45-degree field of view, CFP — 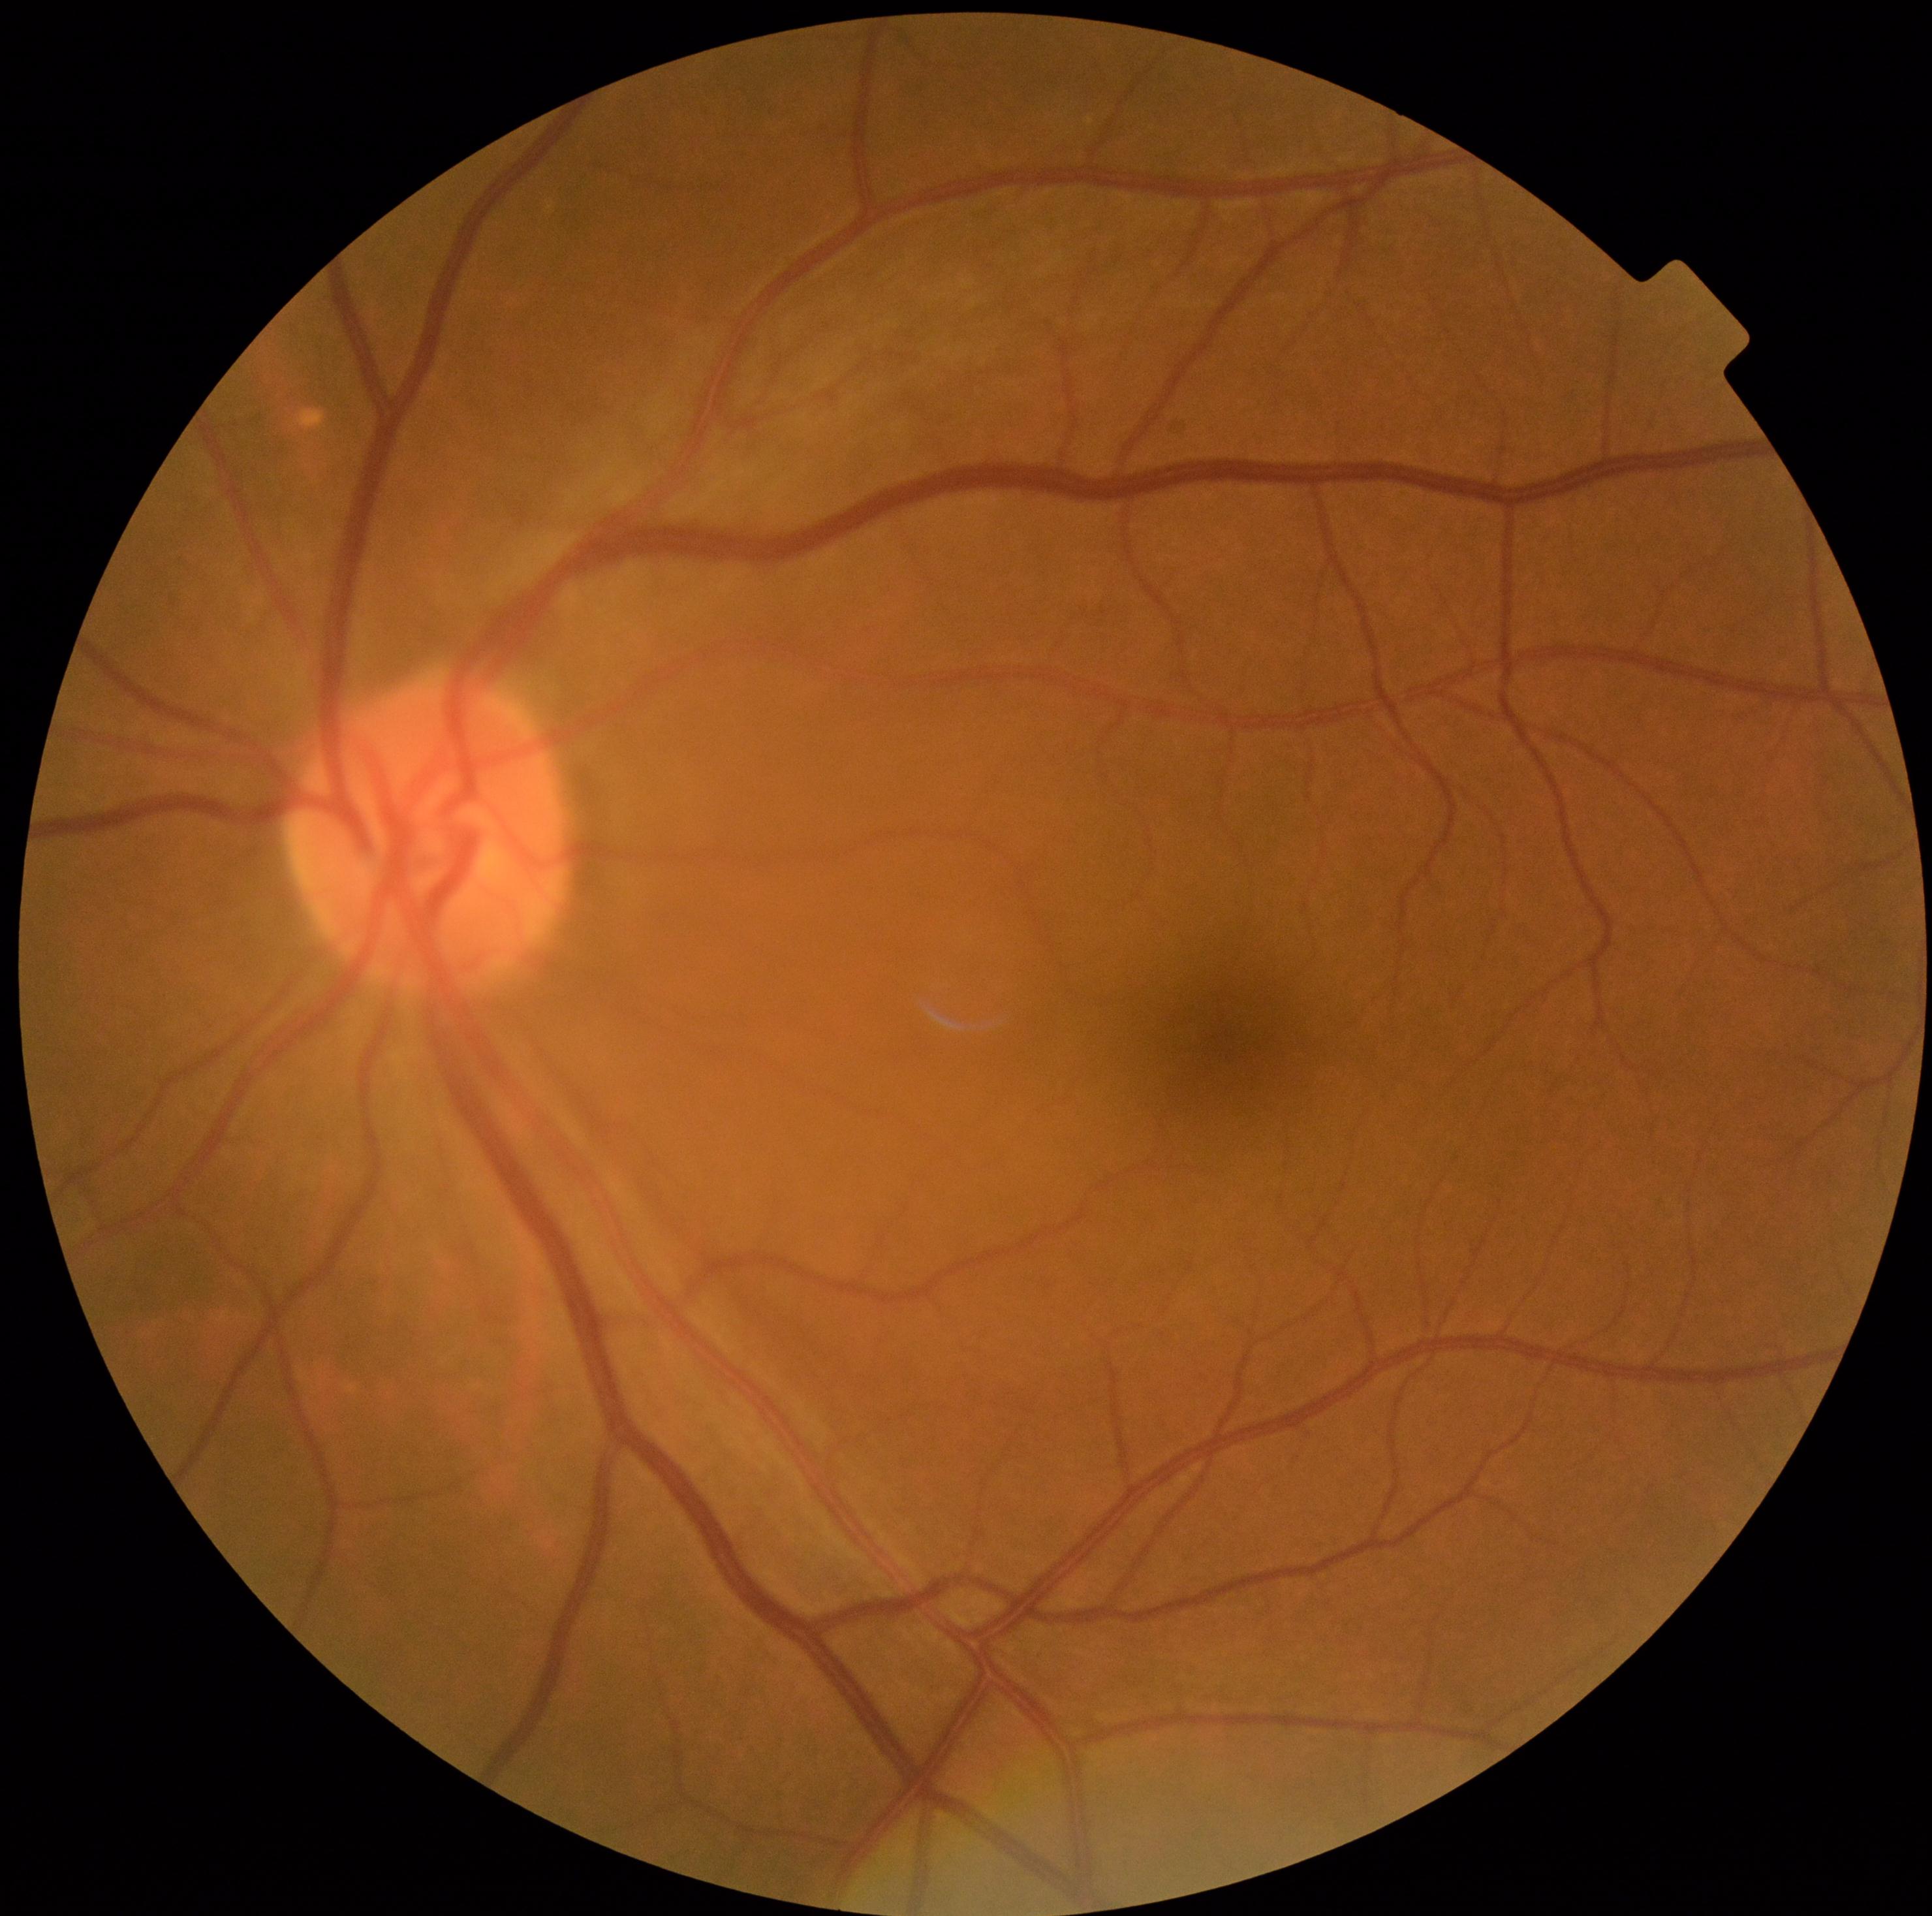 Diabetic retinopathy severity is no apparent diabetic retinopathy (grade 0).